Image size 640x480 · wide-field contact fundus photograph of an infant.
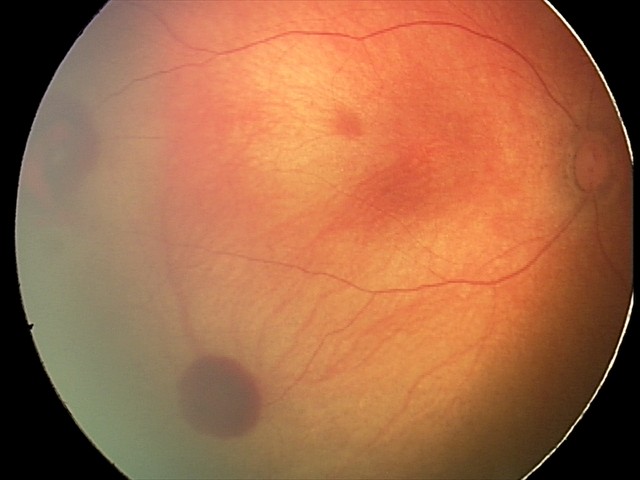
Diagnosis = retinal hemorrhages.